NIDEK AFC-230. 45° field of view:
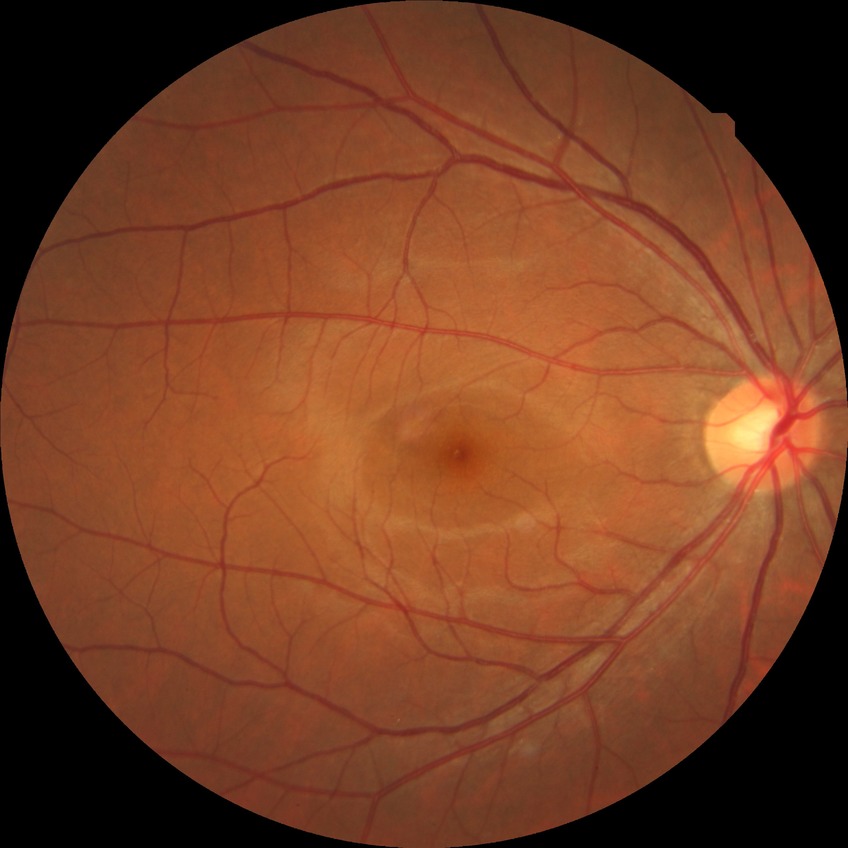

Diabetic retinopathy stage is no diabetic retinopathy.